CFP. 45° field of view.
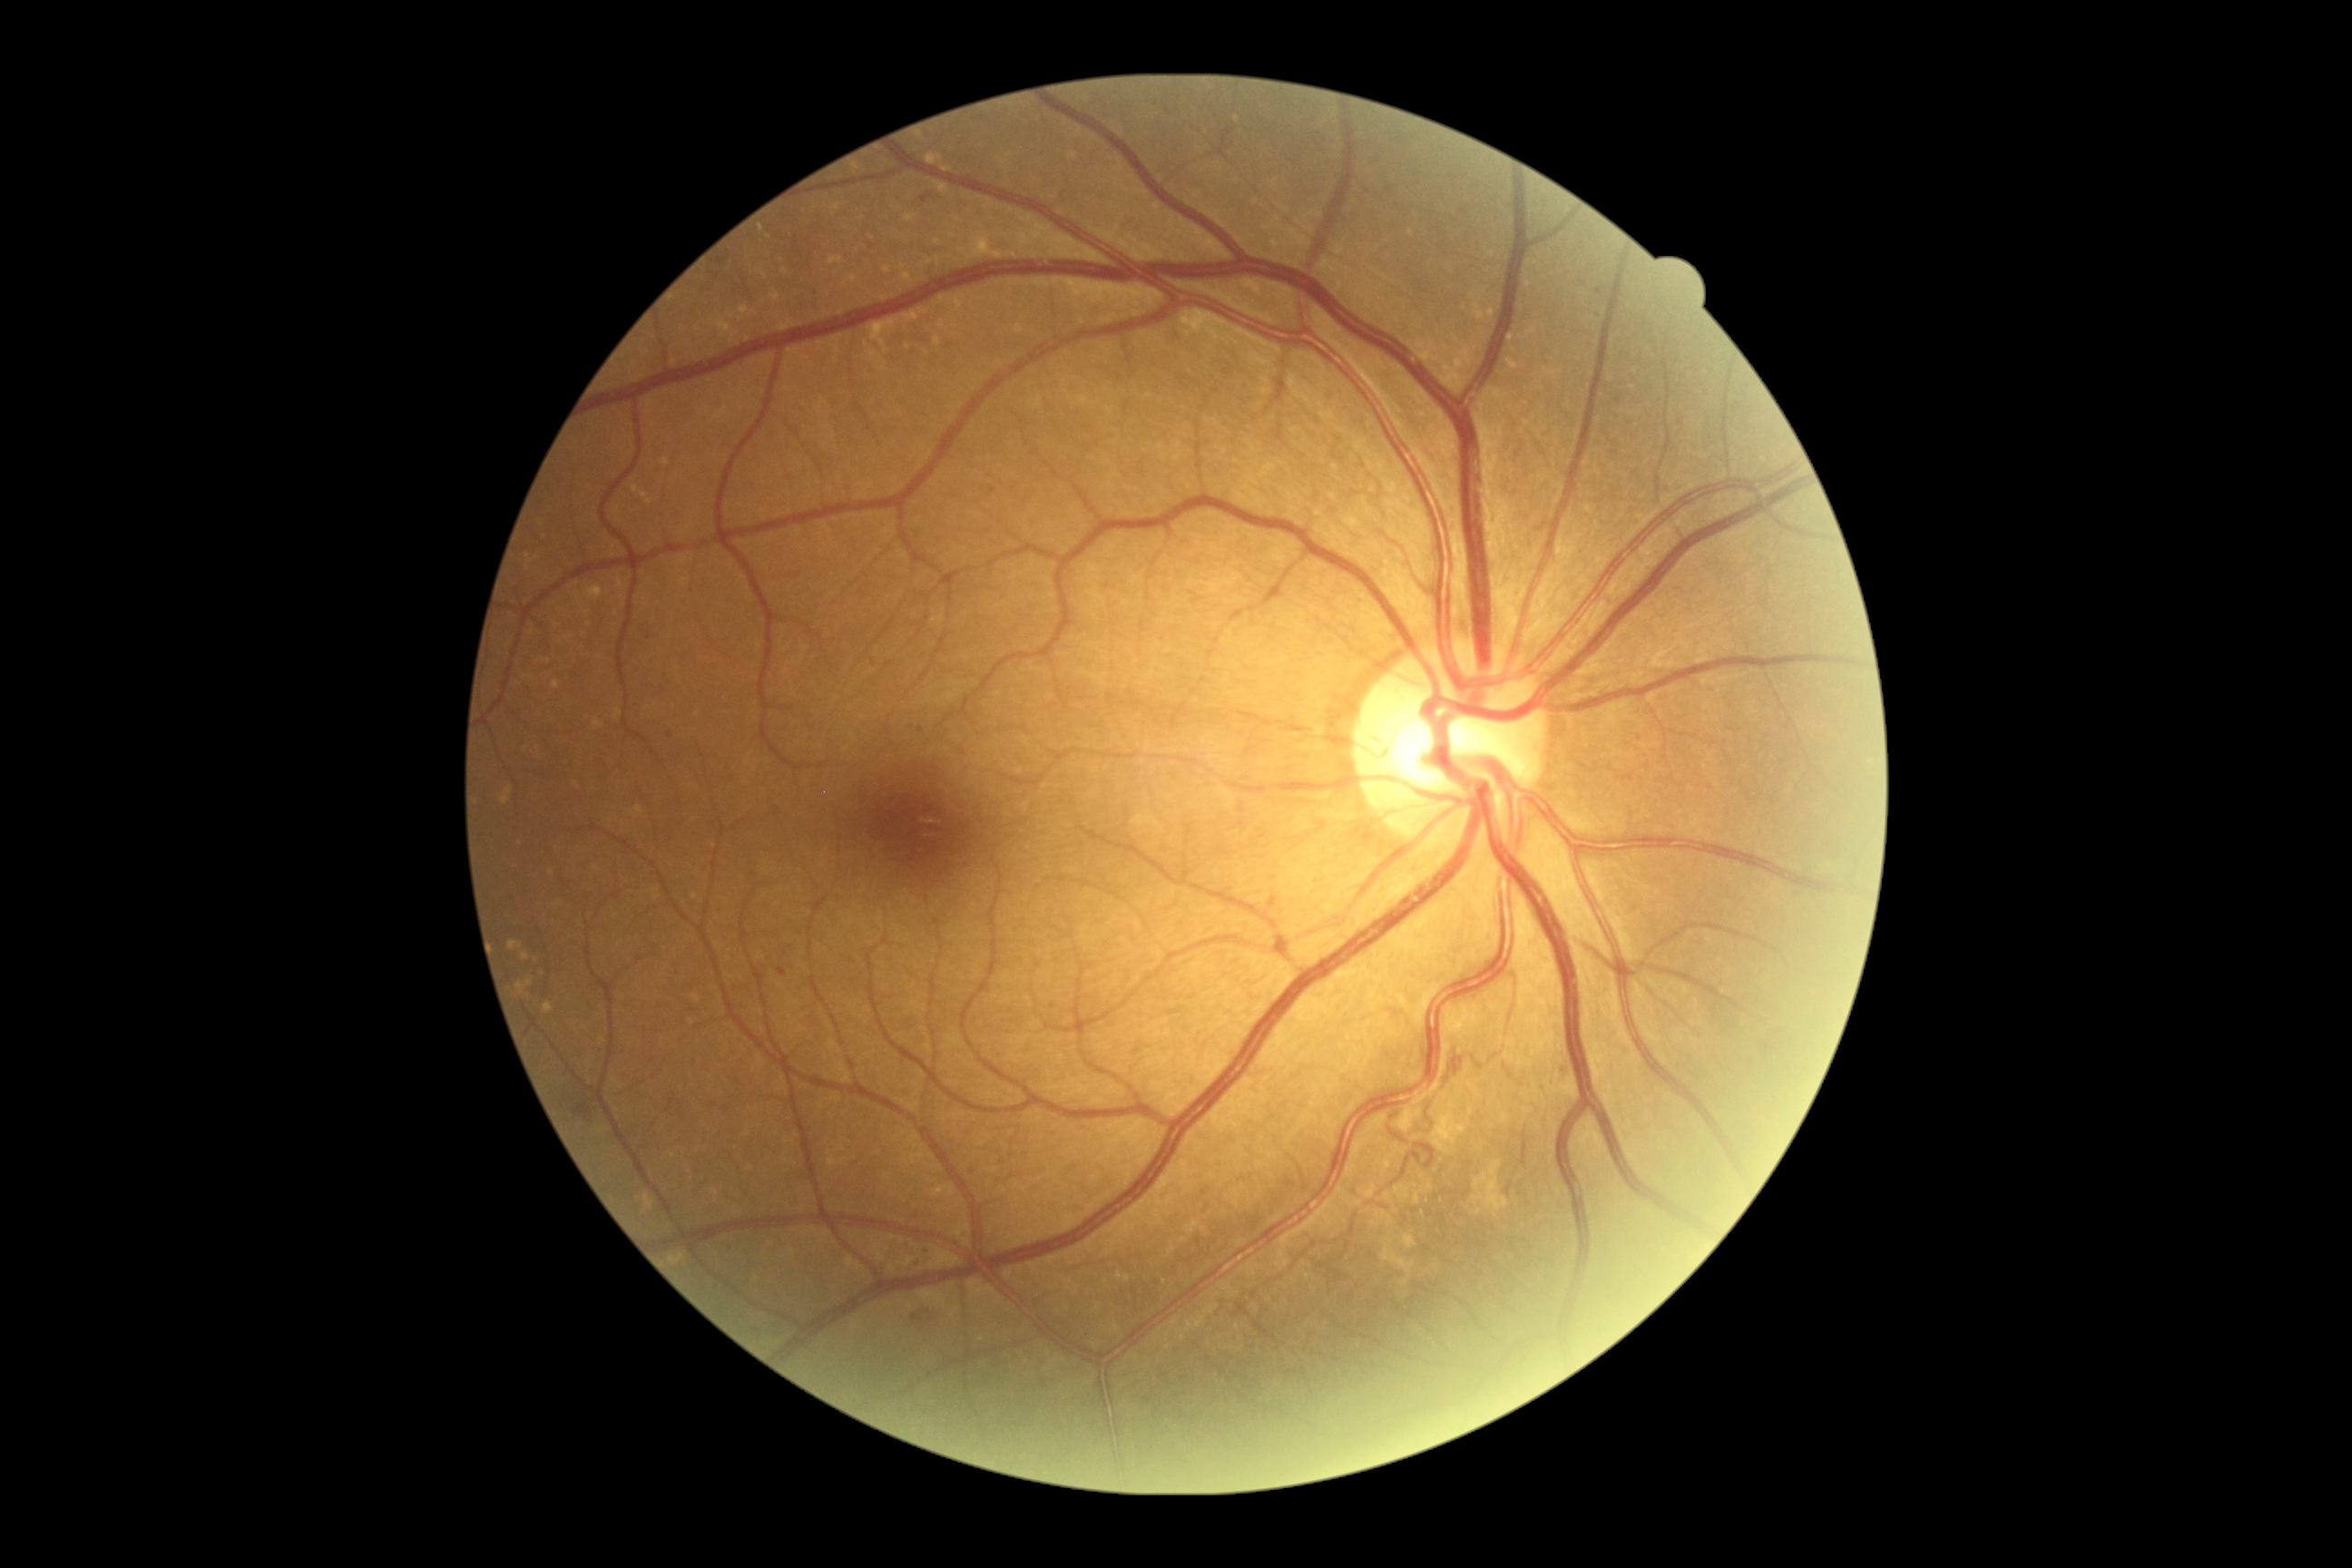
{"partial": true, "dr_grade": 2, "lesions": {"he": null, "se": null, "ex": null, "ma": [[778, 968, 787, 977], [917, 729, 925, 734], [1594, 311, 1605, 322], [921, 1248, 930, 1257], [912, 1260, 923, 1268], [914, 1317, 923, 1322]], "ma_small": [[908, 1247], [670, 735], [926, 200], [1599, 292], [1052, 1007]]}}